Color fundus image
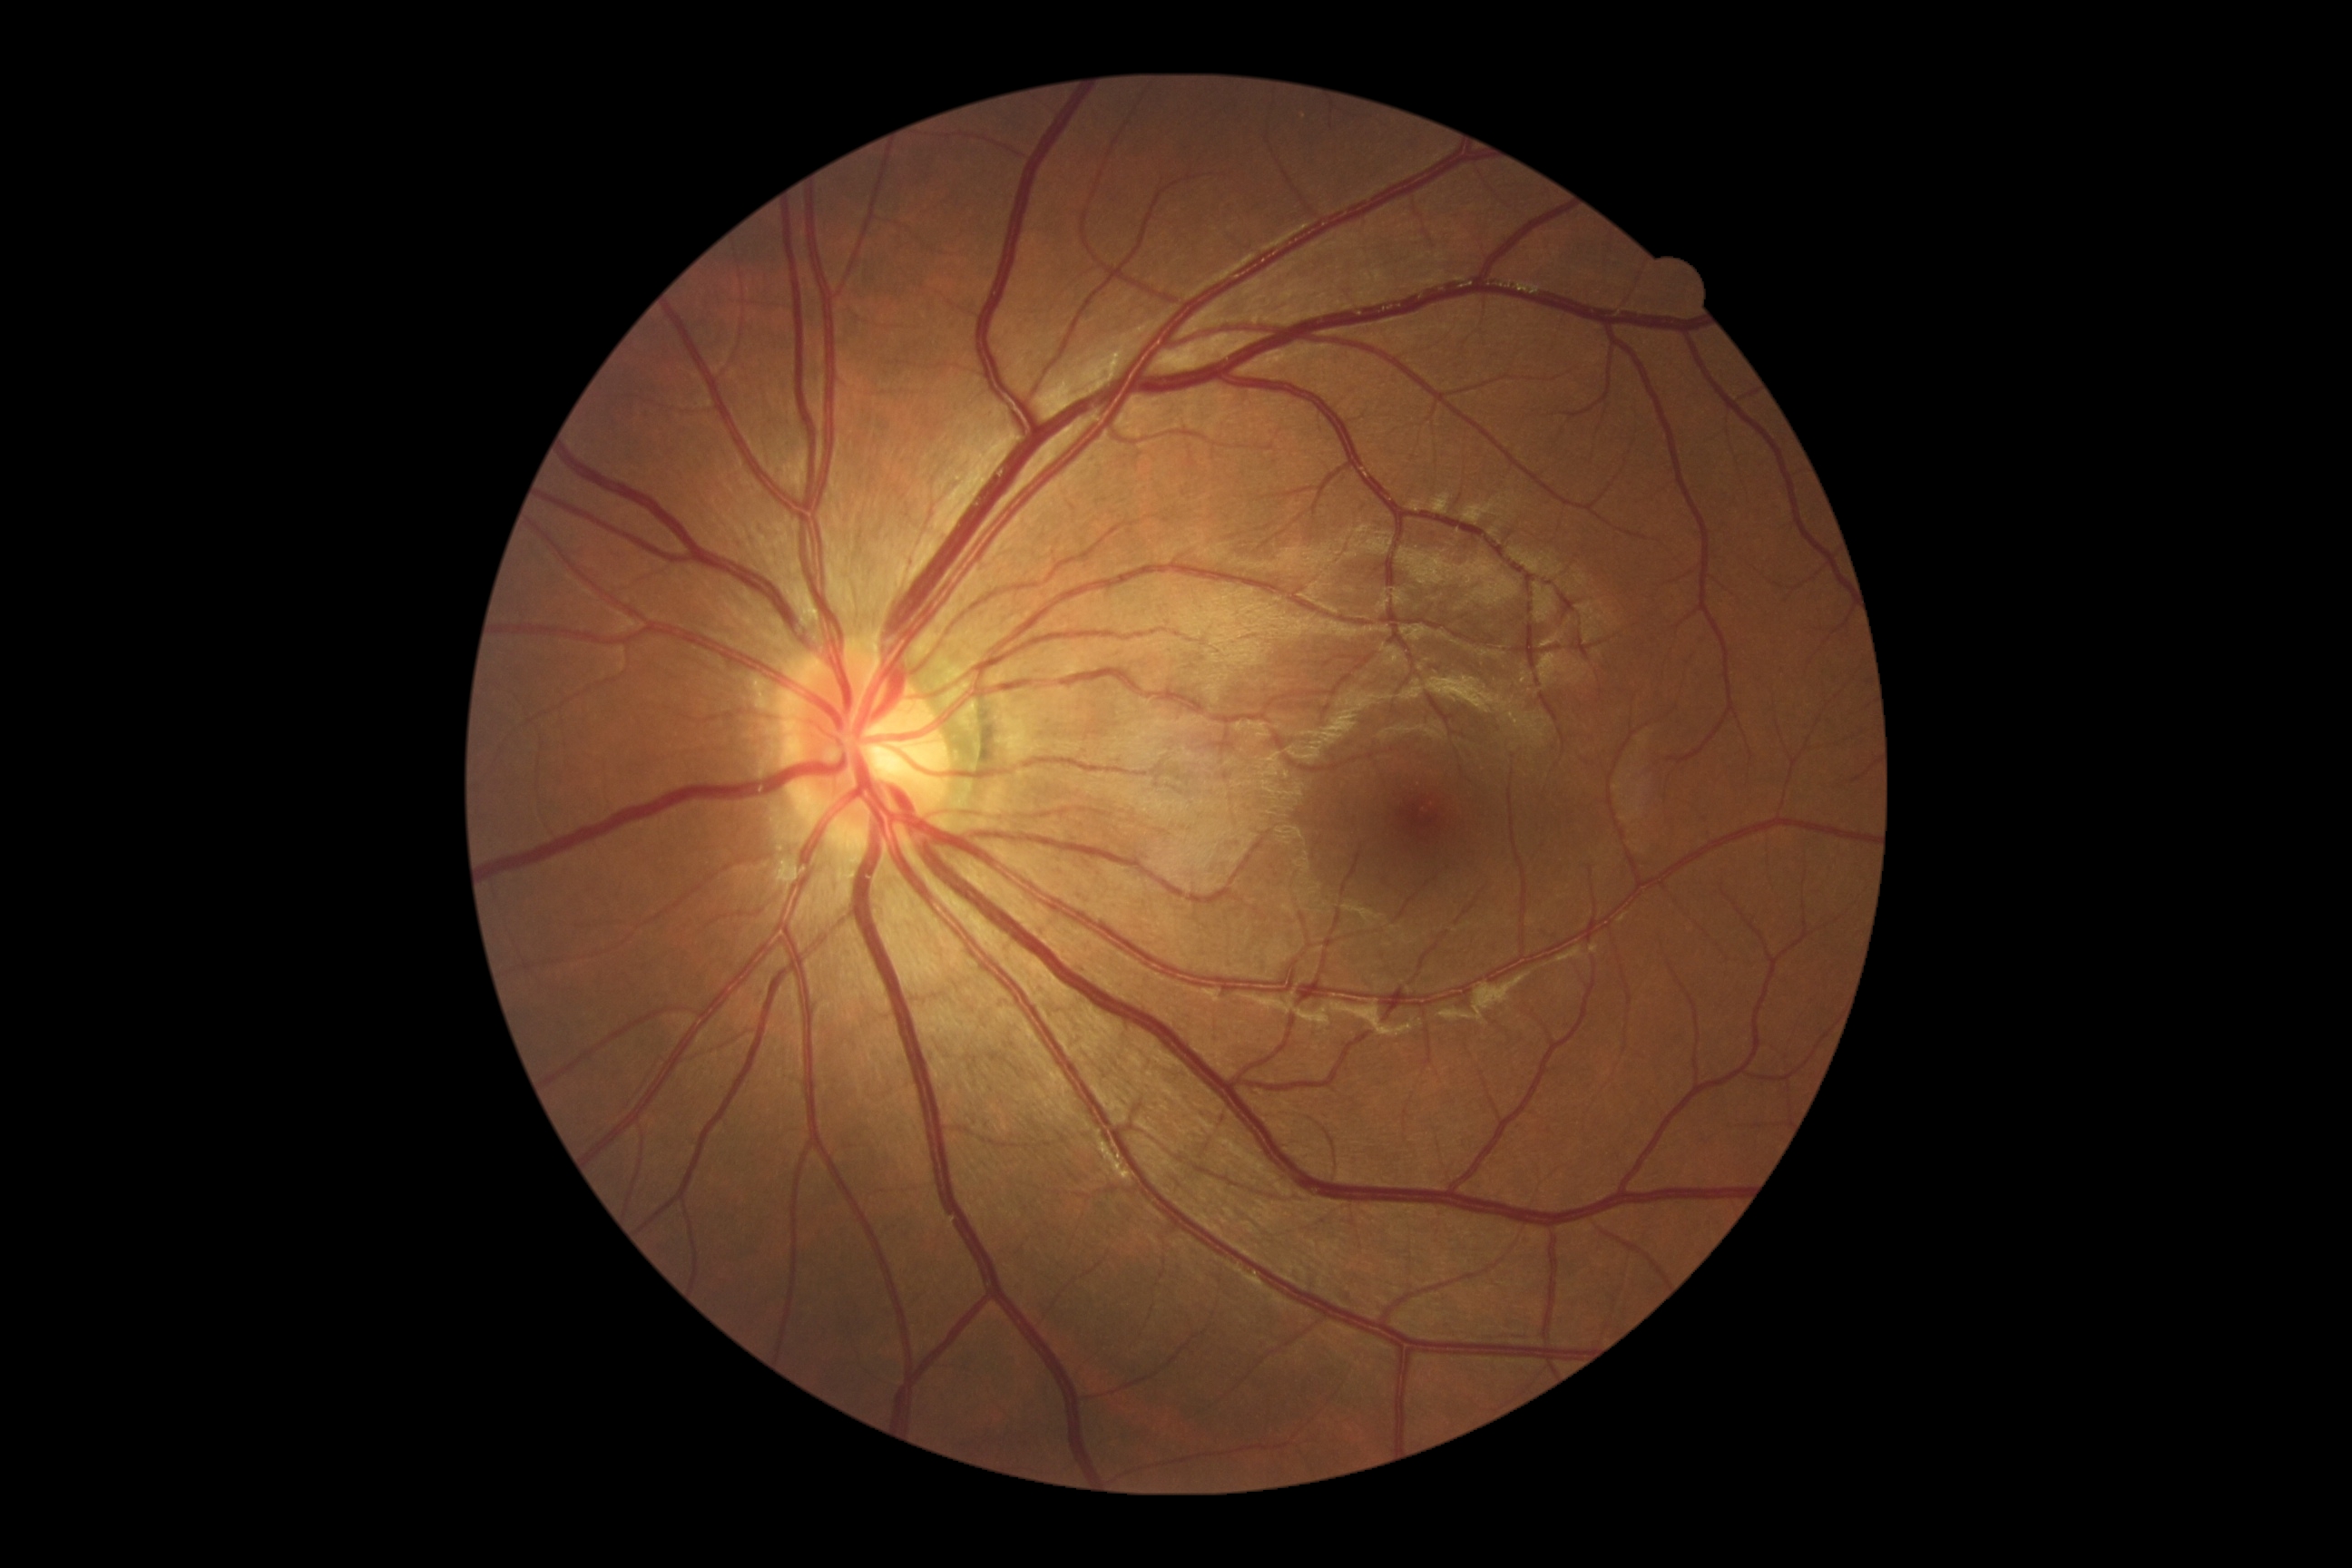

– diabetic retinopathy (DR) — no apparent retinopathy (grade 0) — no visible signs of diabetic retinopathy